DR severity per modified Davis staging · no pharmacologic dilation.
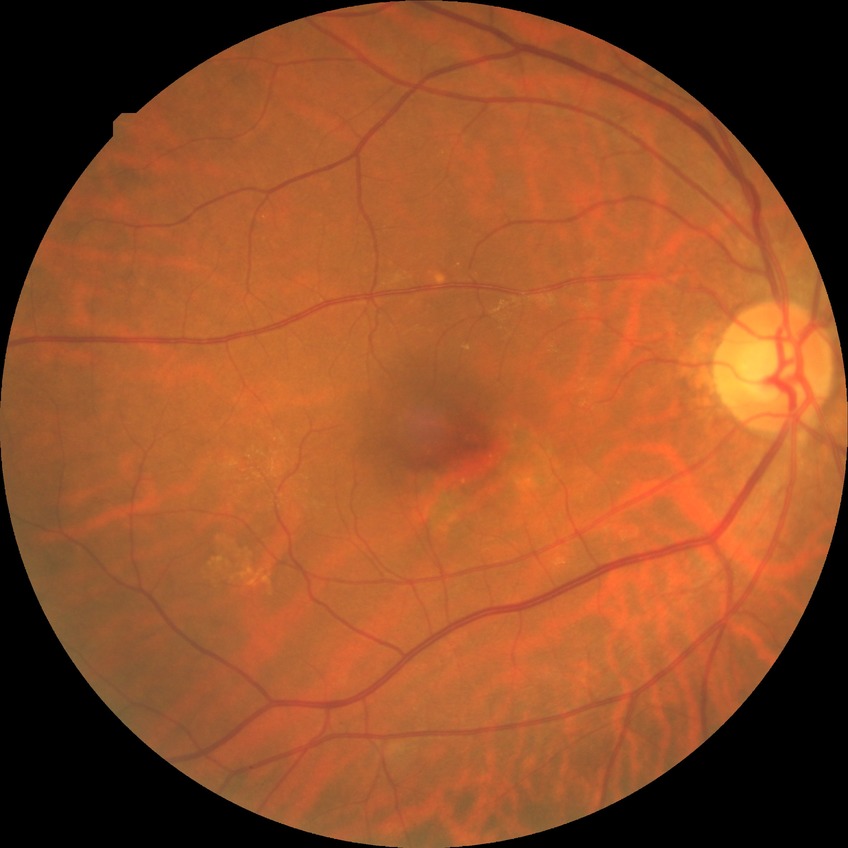

Davis stage = NDR.